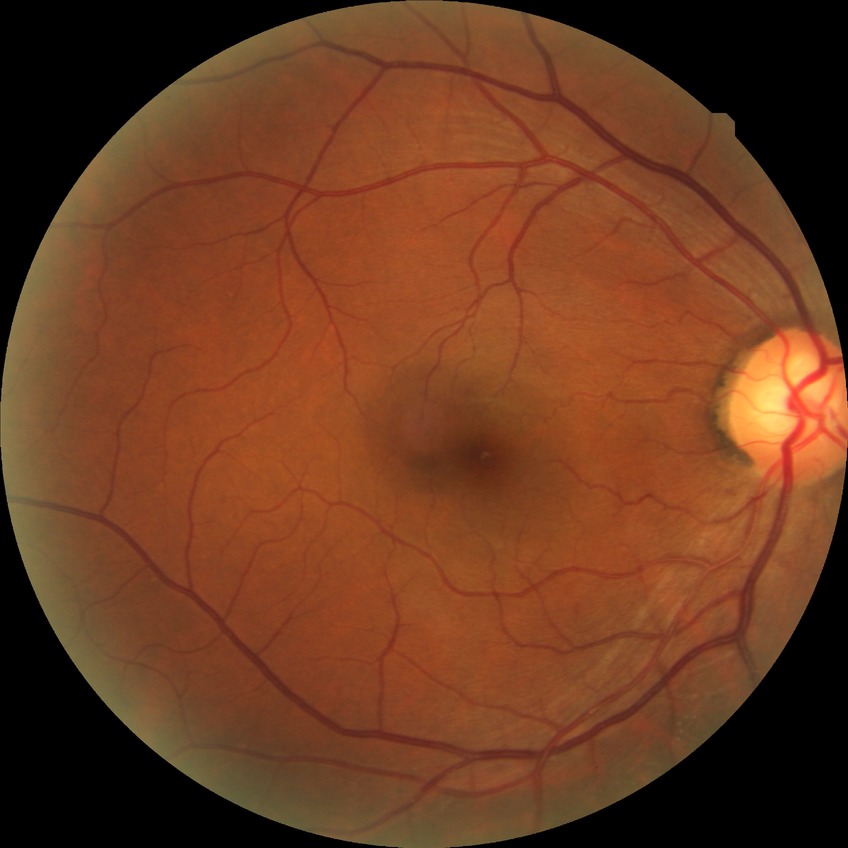
davis_grade: no diabetic retinopathy (NDR)